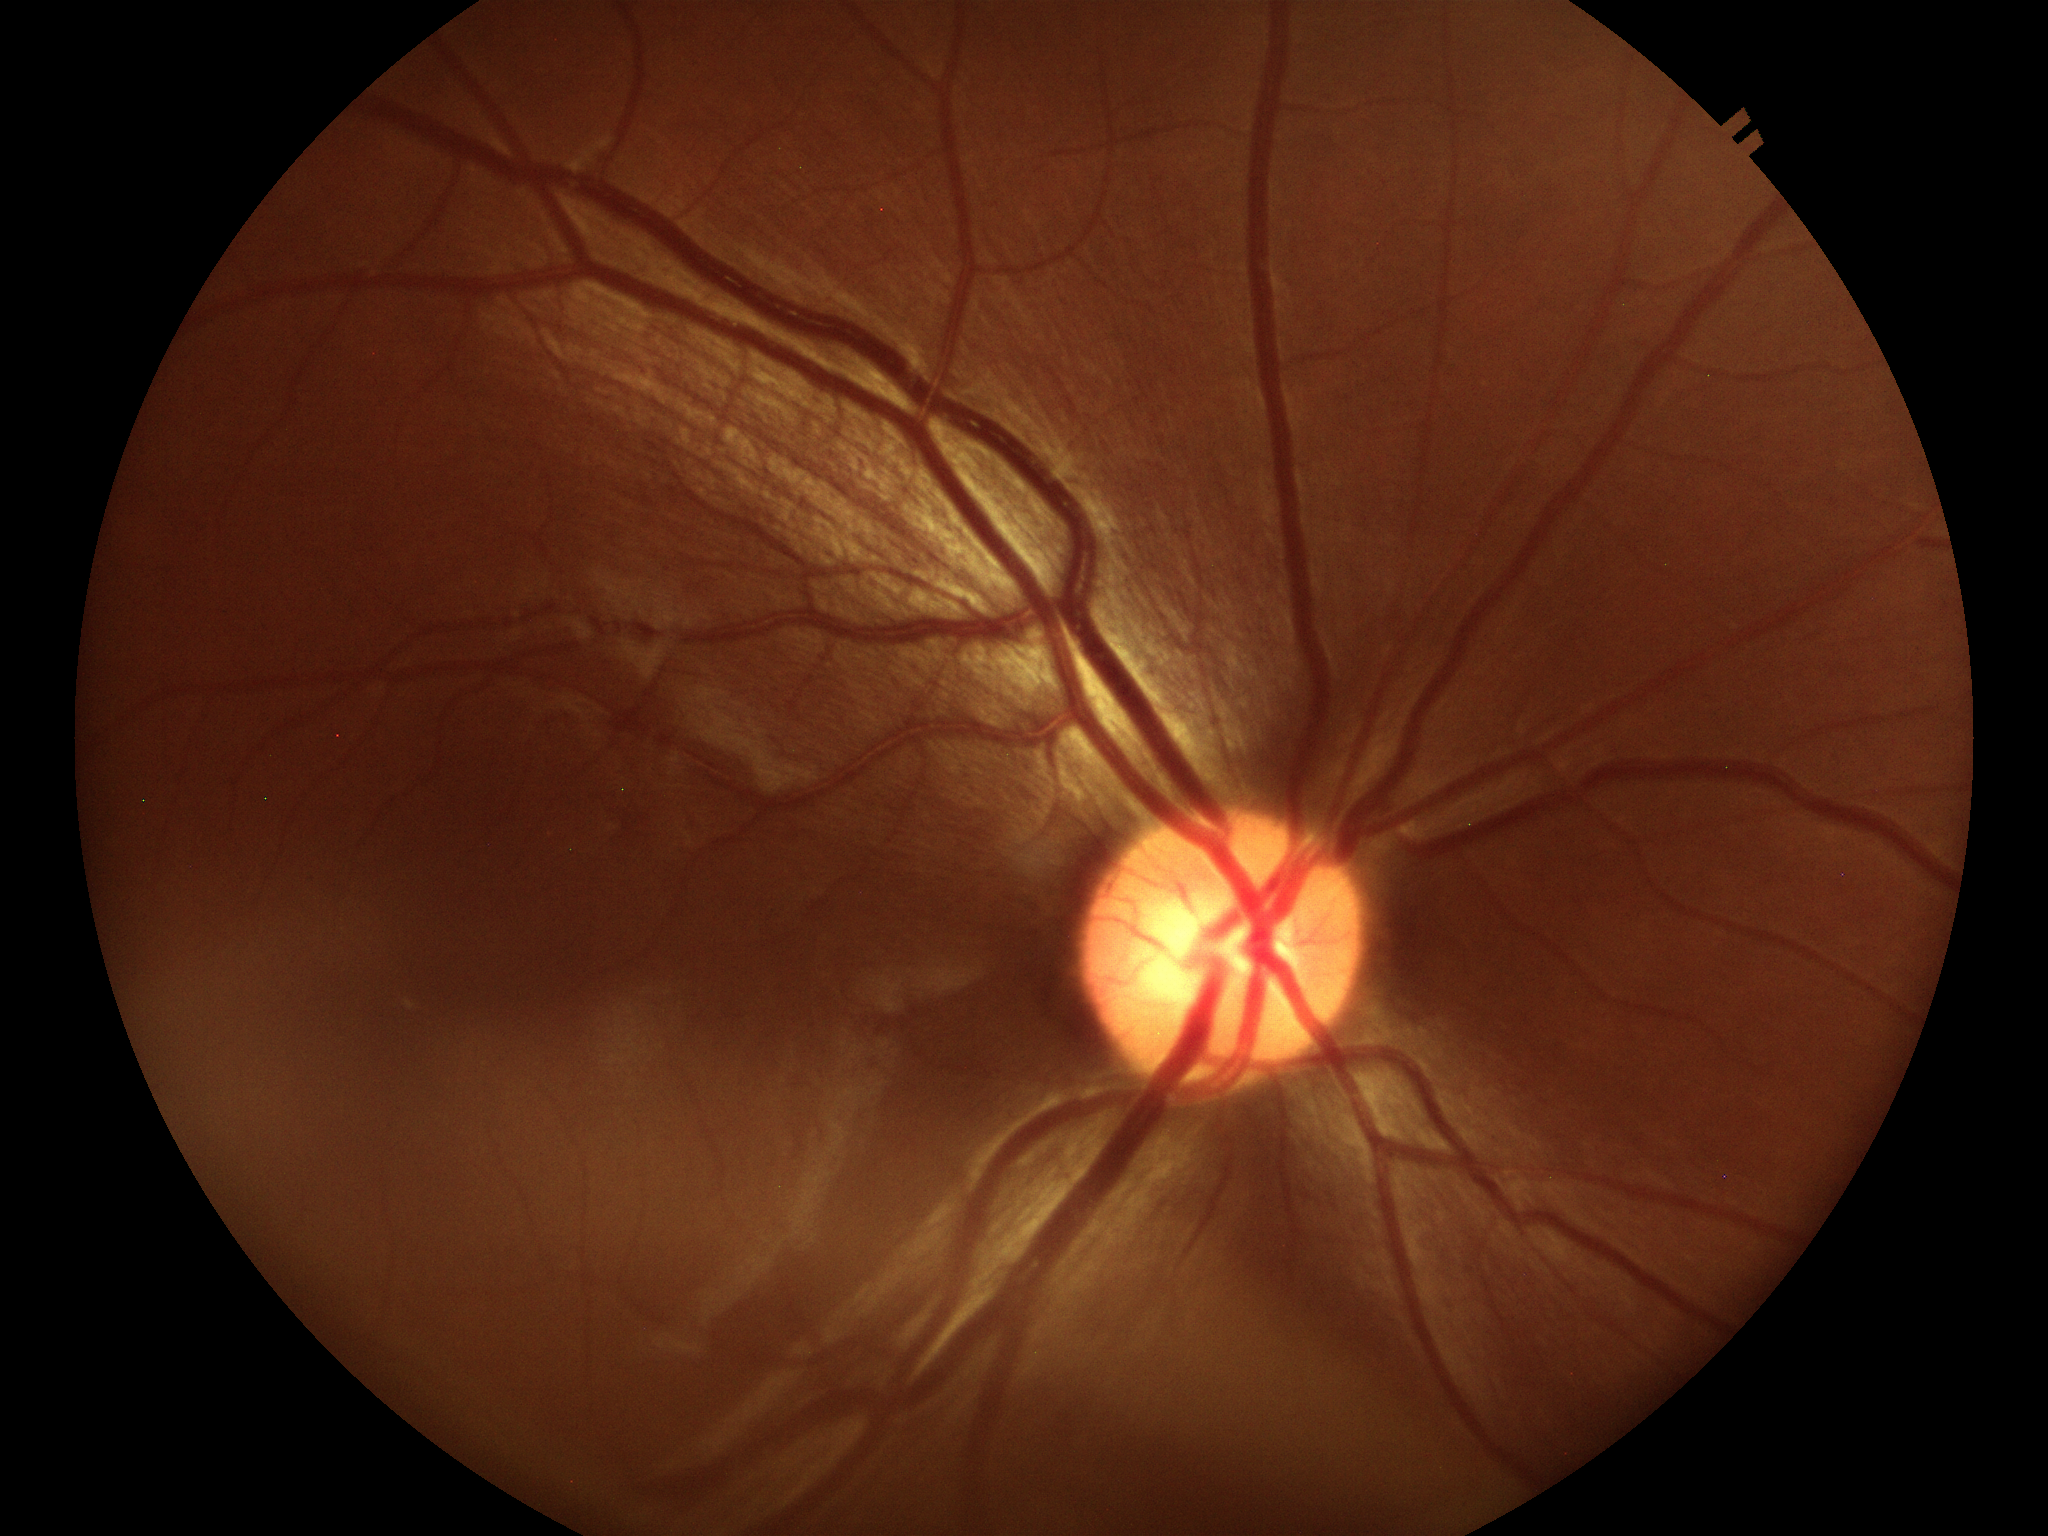

Vertical cup-disc ratio (VCDR) is 0.53. No evidence of glaucoma. Horizontal cup-disc ratio (HCDR) is 0.59.